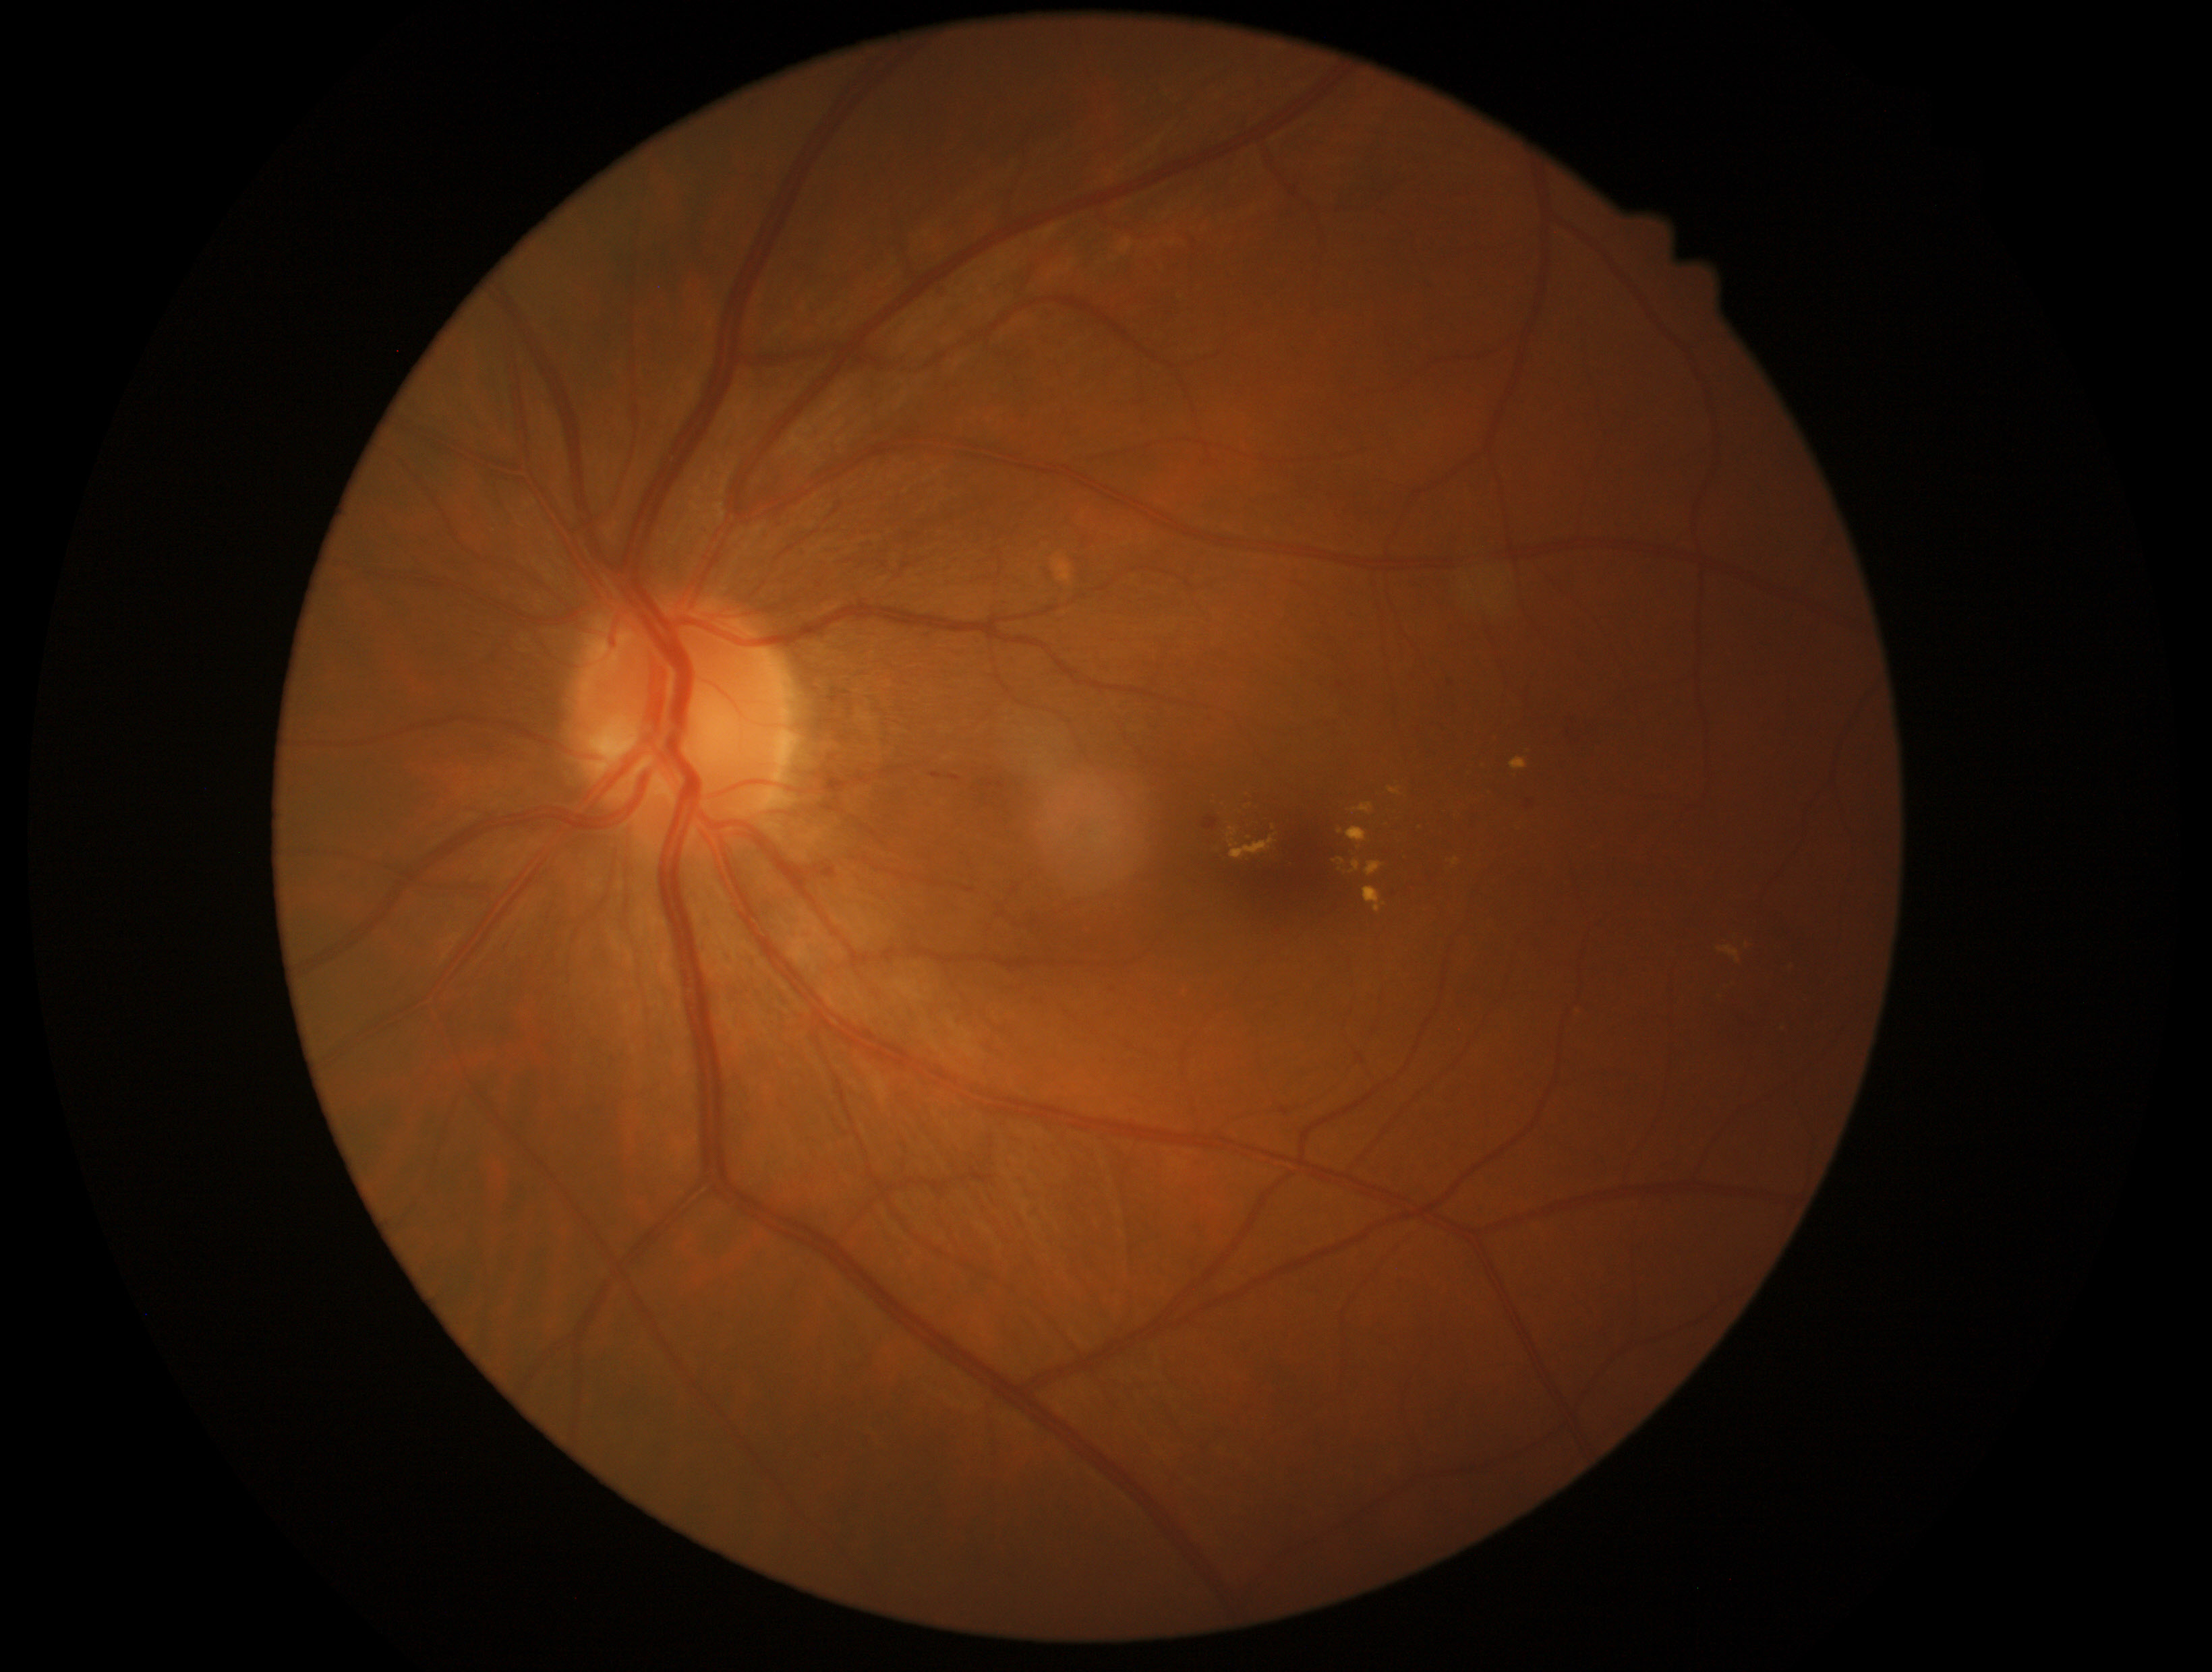
Diabetic retinopathy (DR) is grade 2 (moderate NPDR)
Representative lesions:
soft exudates (SEs): not present
microaneurysms (MAs): (left=1204, top=816, right=1219, bottom=830); (left=1527, top=800, right=1533, bottom=810); (left=1336, top=682, right=1345, bottom=688)
Smaller MAs around 1451/684; 1419/731
hard exudates (EXs) (subset): (left=1510, top=757, right=1527, bottom=769); (left=1389, top=787, right=1401, bottom=796); (left=1347, top=827, right=1367, bottom=843); (left=1364, top=888, right=1387, bottom=914); (left=1227, top=827, right=1239, bottom=838); (left=1366, top=862, right=1383, bottom=876); (left=1231, top=835, right=1277, bottom=858); (left=1352, top=861, right=1362, bottom=873); (left=1349, top=803, right=1374, bottom=815); (left=1719, top=945, right=1739, bottom=962); (left=1229, top=839, right=1239, bottom=847); (left=1452, top=858, right=1460, bottom=865)
Smaller EXs around 1341/831; 1342/860
hemorrhages (HEs): (left=1564, top=711, right=1600, bottom=752); (left=930, top=773, right=943, bottom=779); (left=948, top=775, right=962, bottom=783)